Retinal fundus photograph:
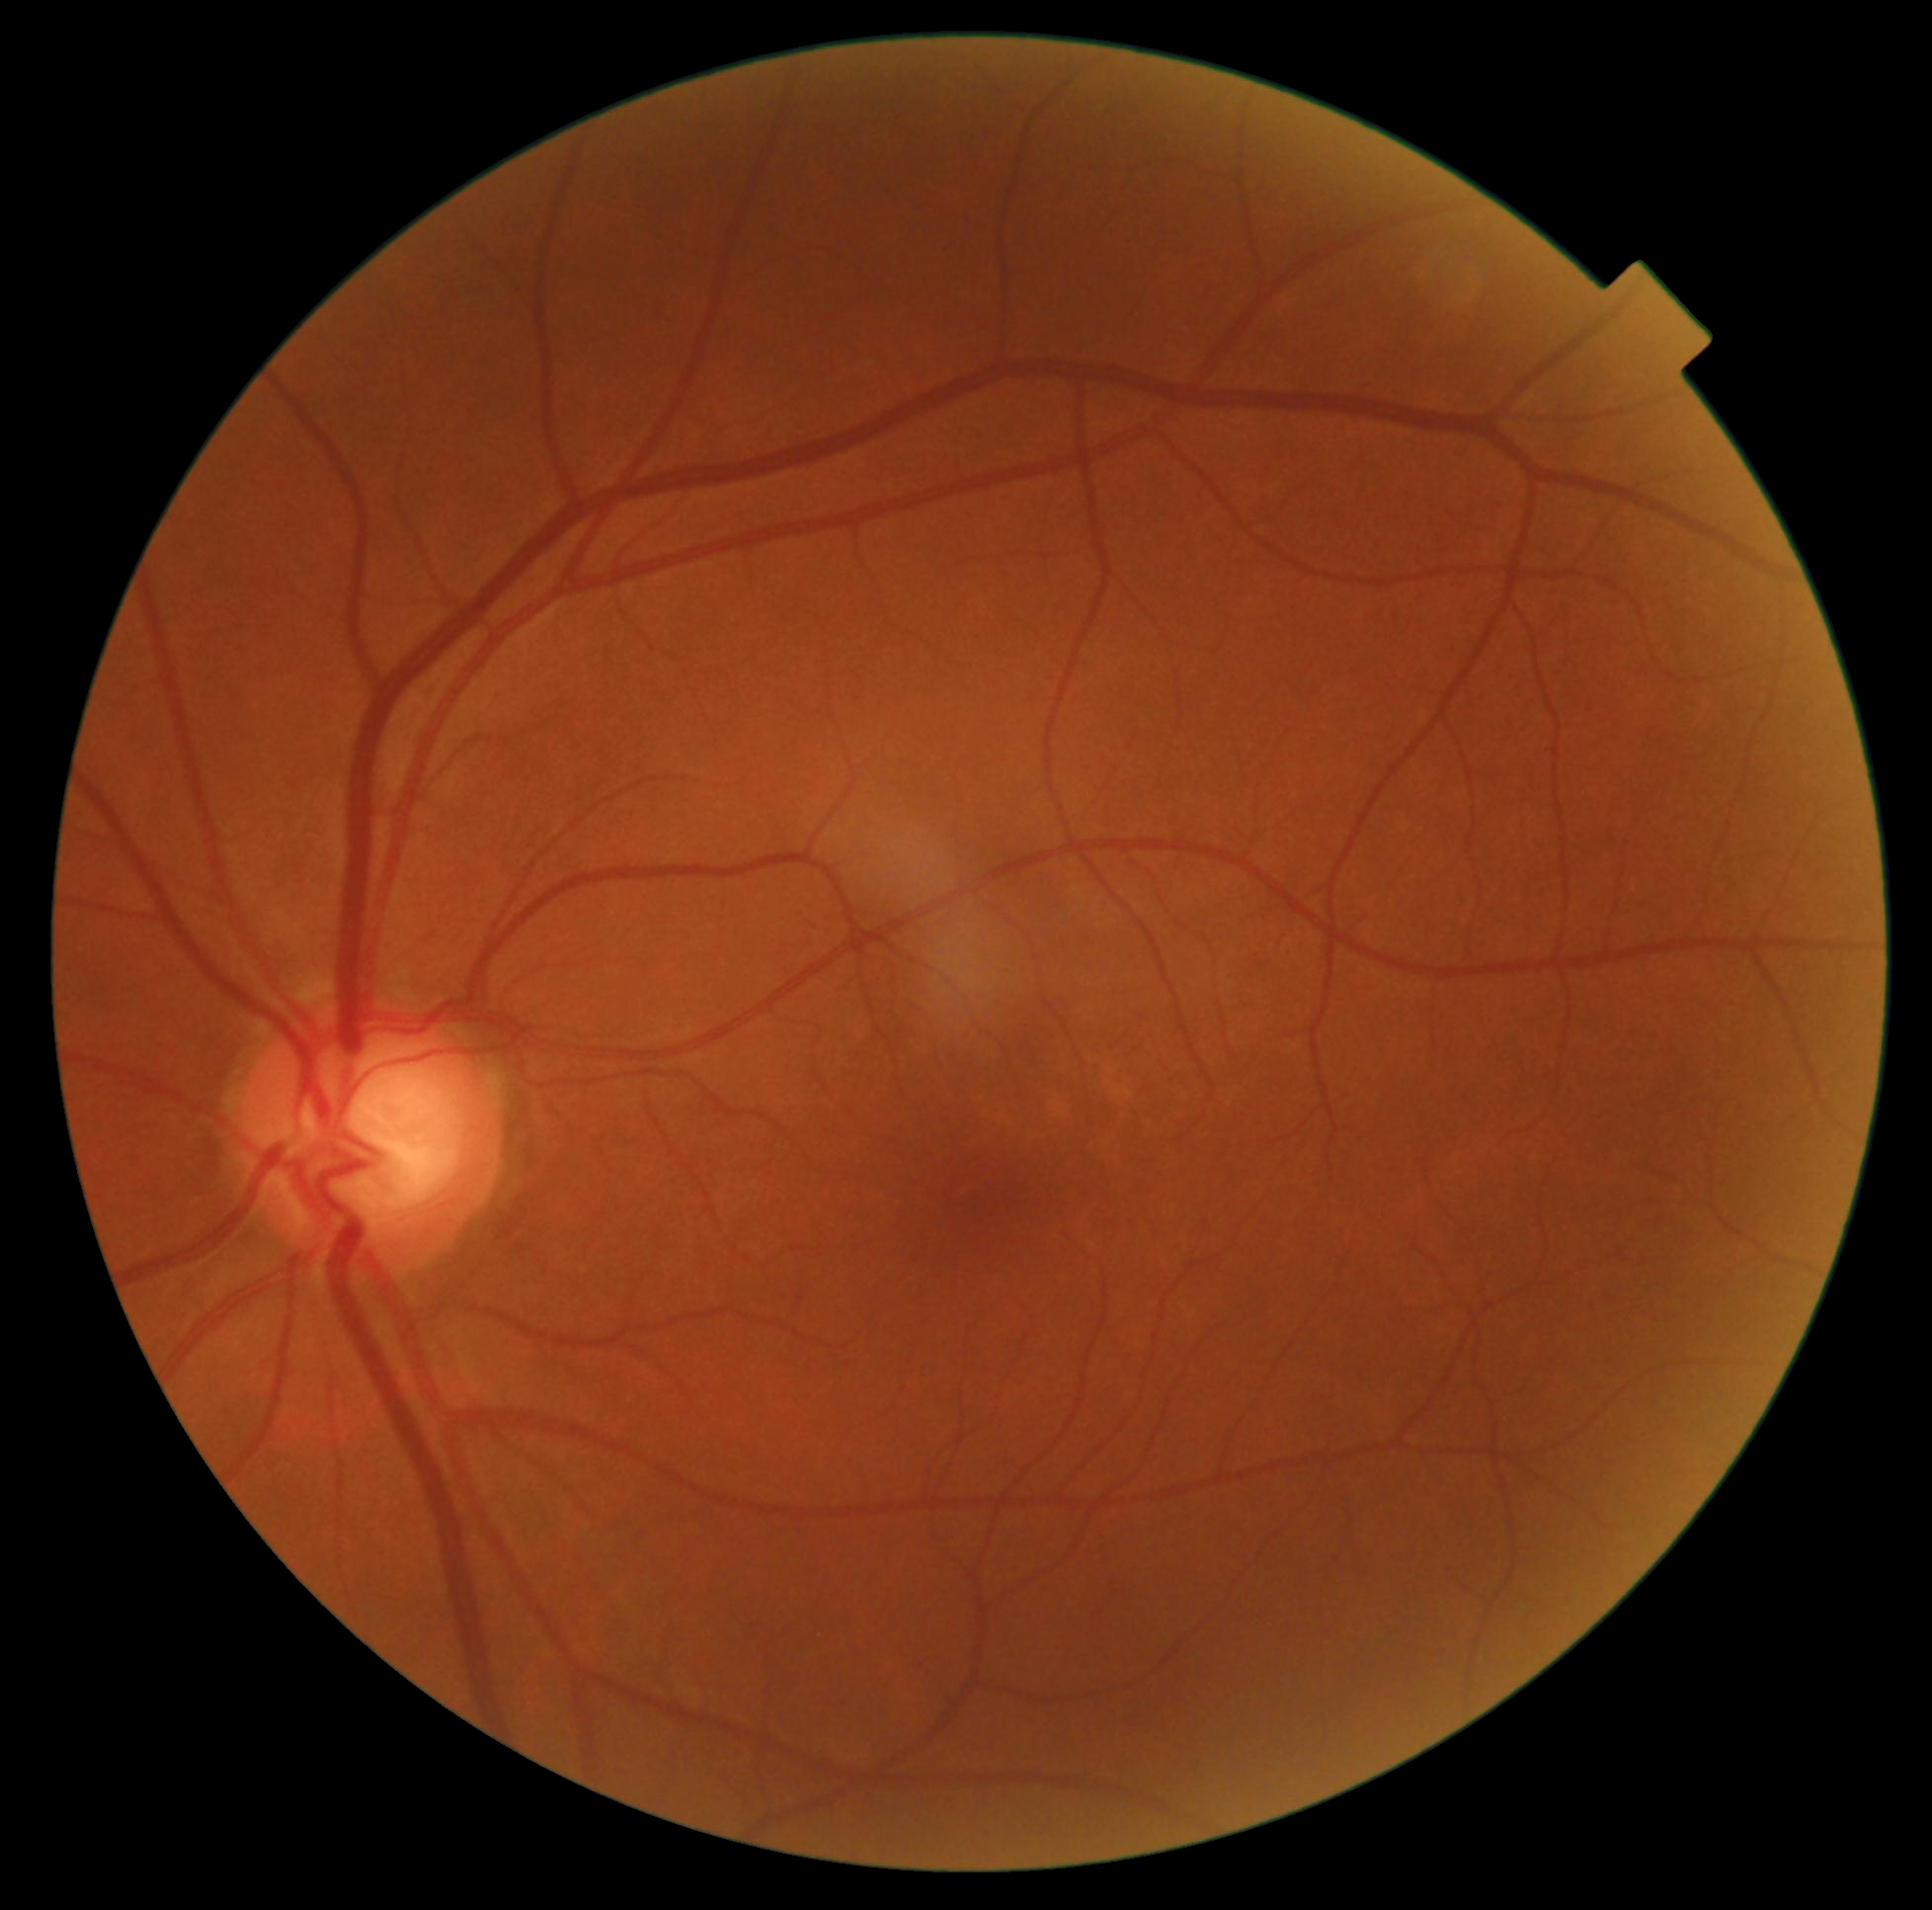 No signs of diabetic retinopathy. DR stage is grade 0 (no apparent retinopathy).